FOV: 45 degrees — 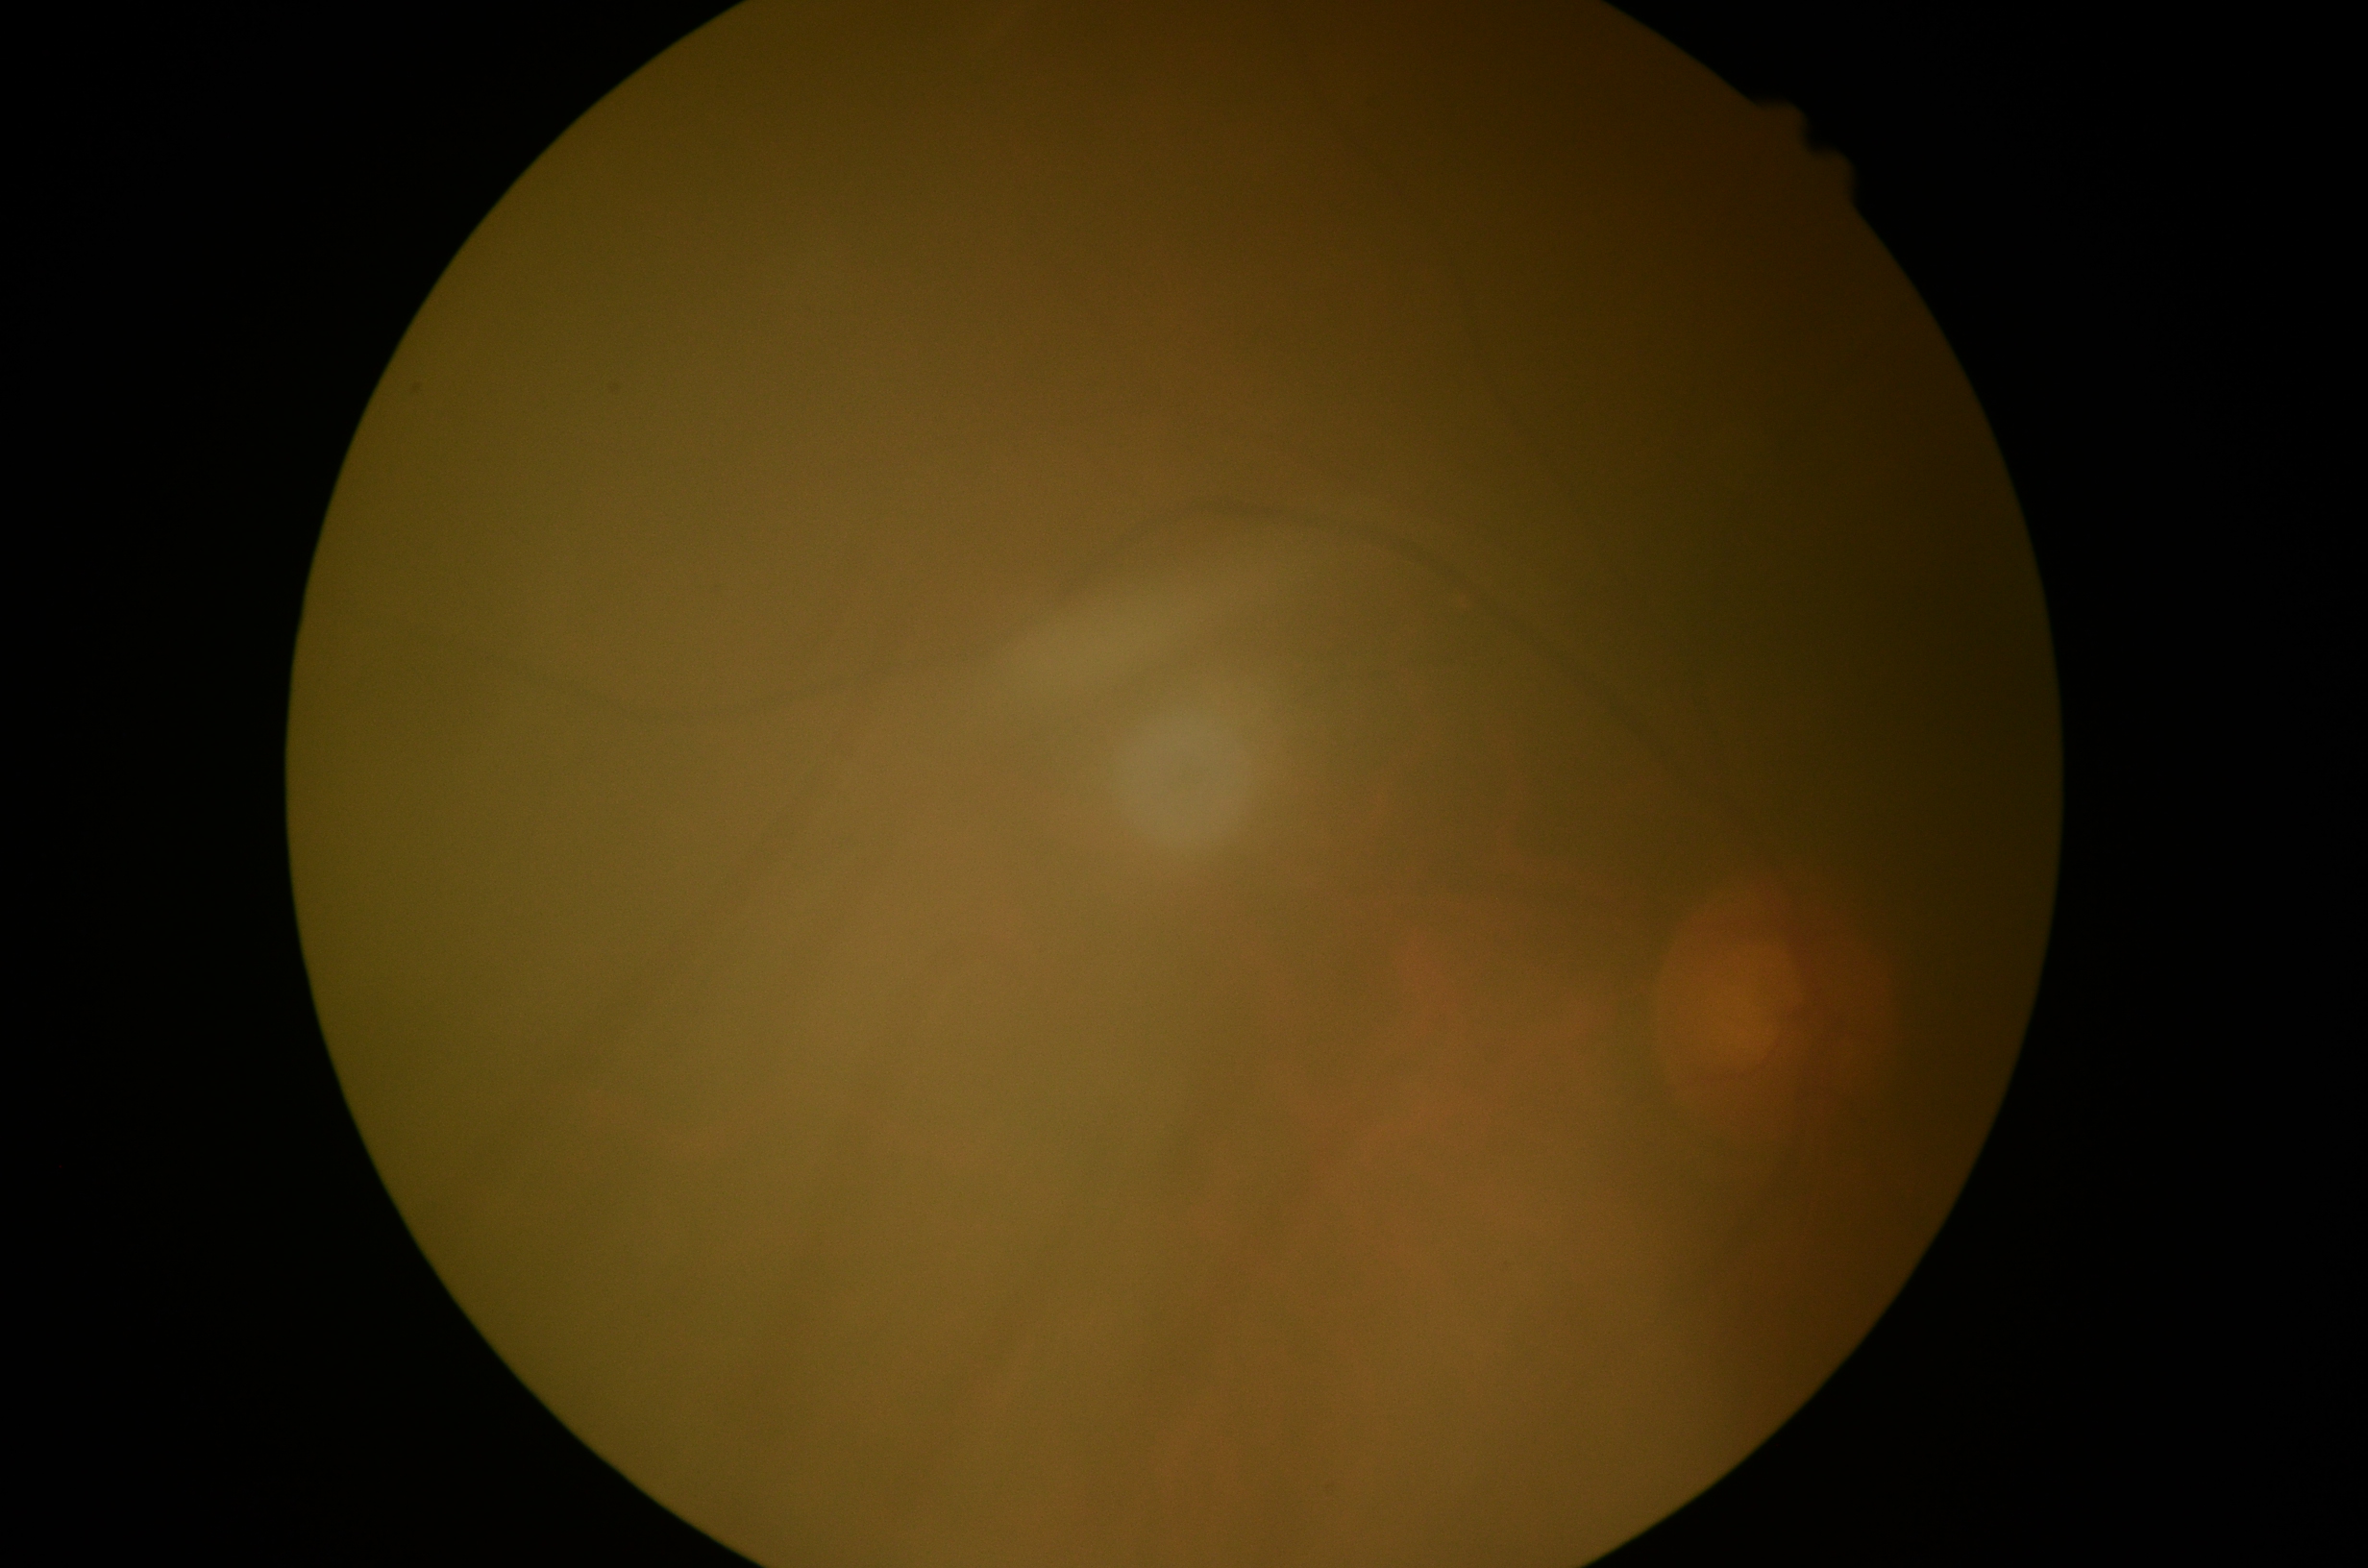
diabetic retinopathy (DR) = ungradable due to poor image quality.